Captured with the Phoenix ICON (100° field of view). Phoenix ICON wide-field infant fundus image
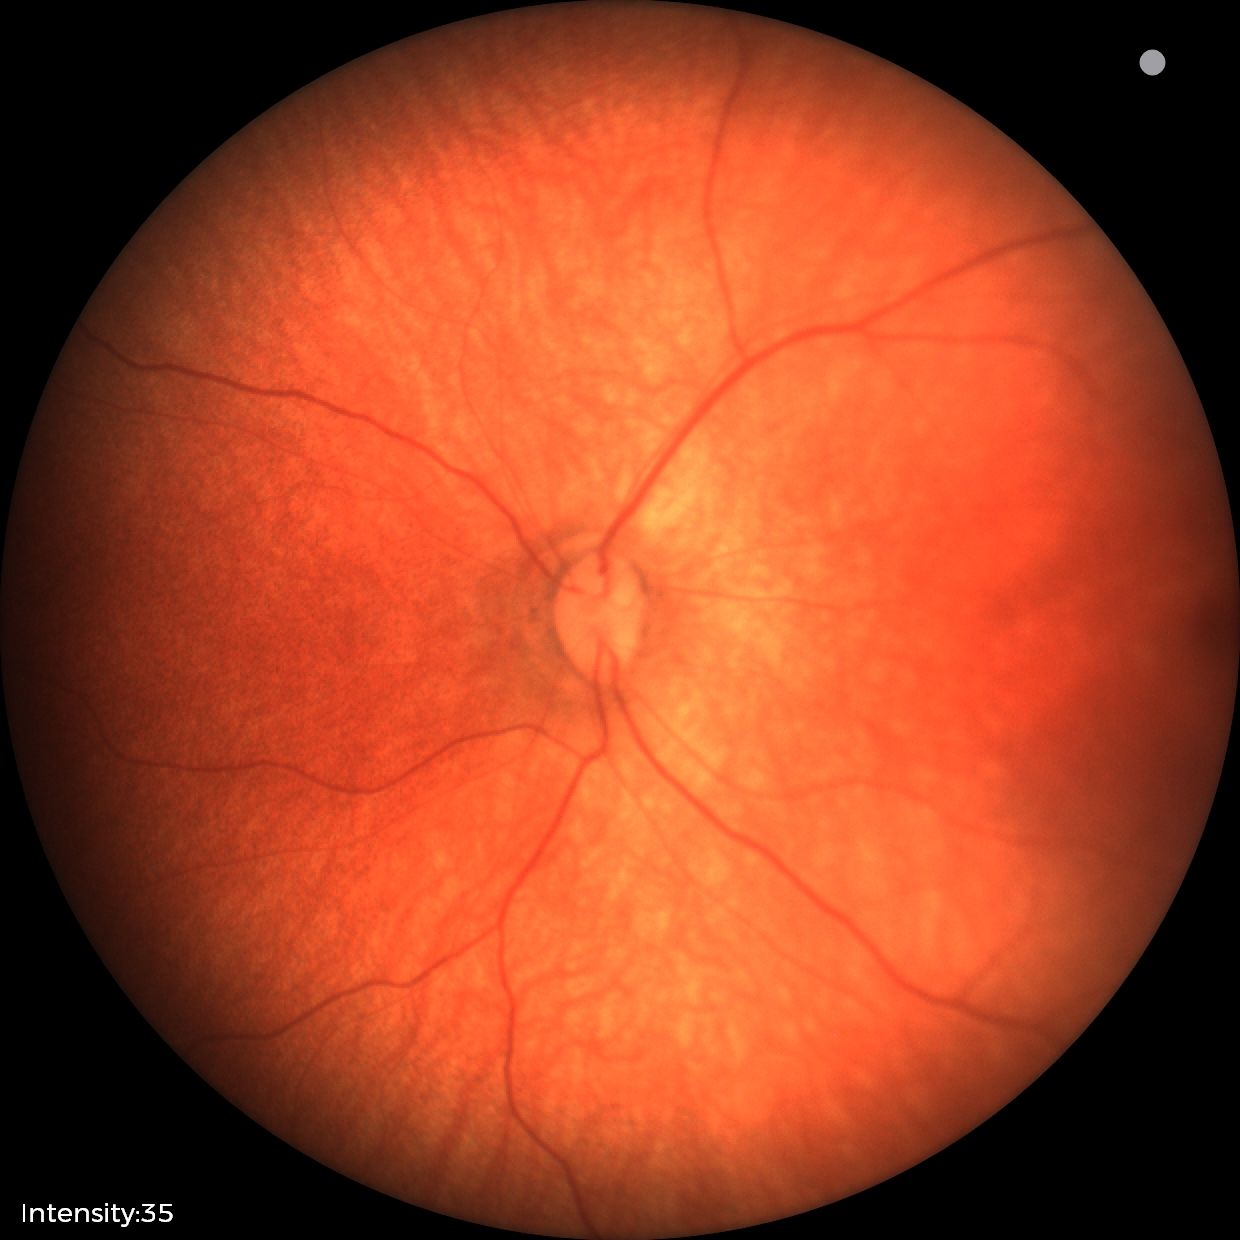

Screening examination with no abnormal retinal findings.